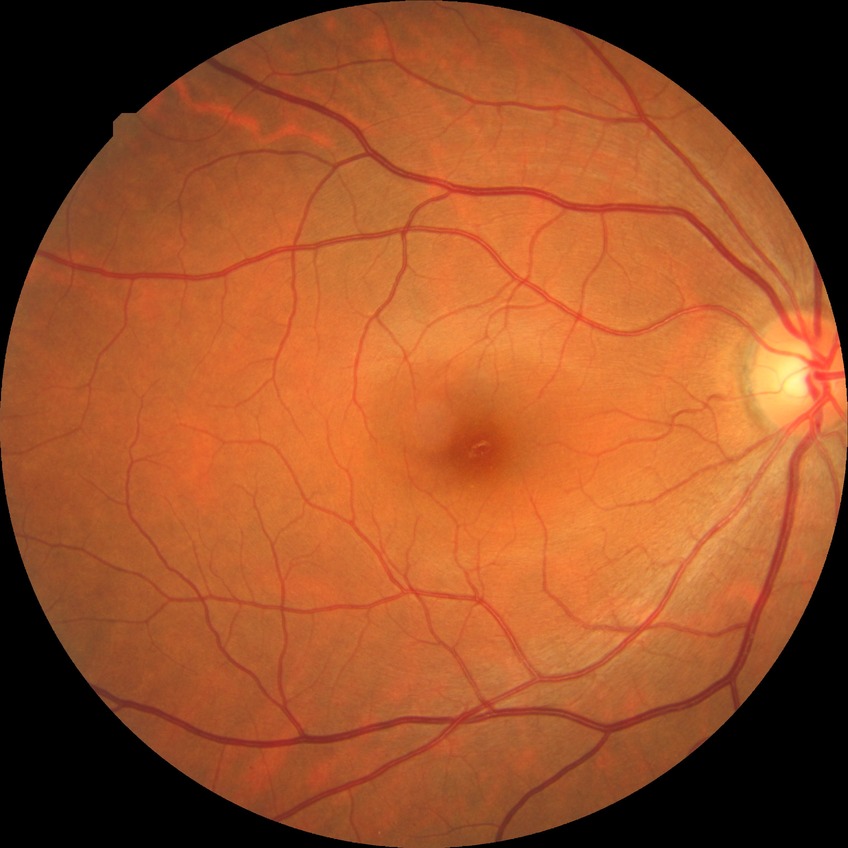

Diabetic retinopathy (DR) is no diabetic retinopathy (NDR).